Wide-field contact fundus photograph of an infant.
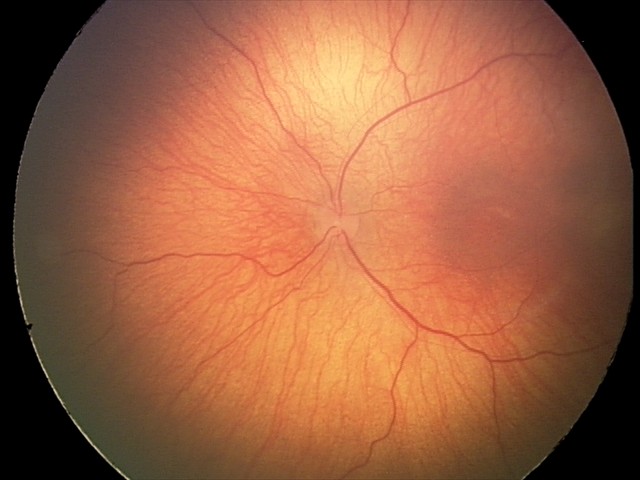

From an examination with diagnosis of status post ROP.
Without plus disease.